Image size 1440x1080 · pediatric wide-field fundus photograph — 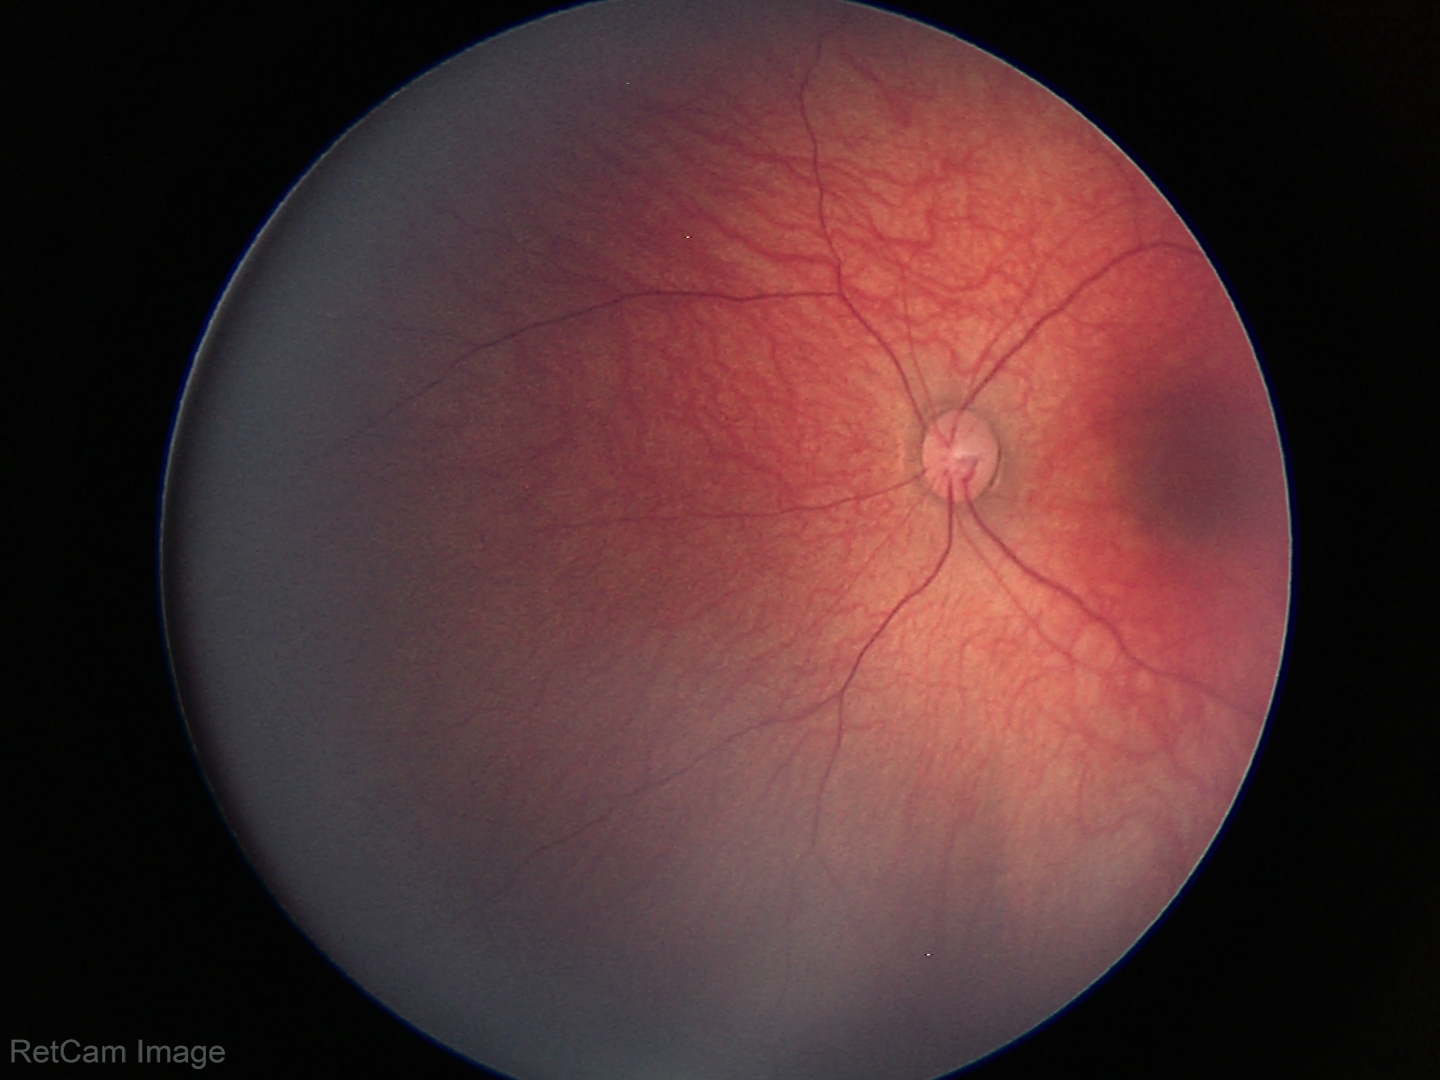 Finding: no abnormalities